Camera: Nidek AFC-330
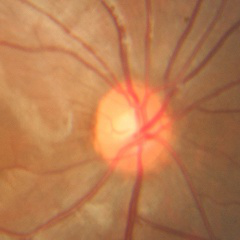

Glaucoma diagnosis: no glaucomatous optic neuropathy.